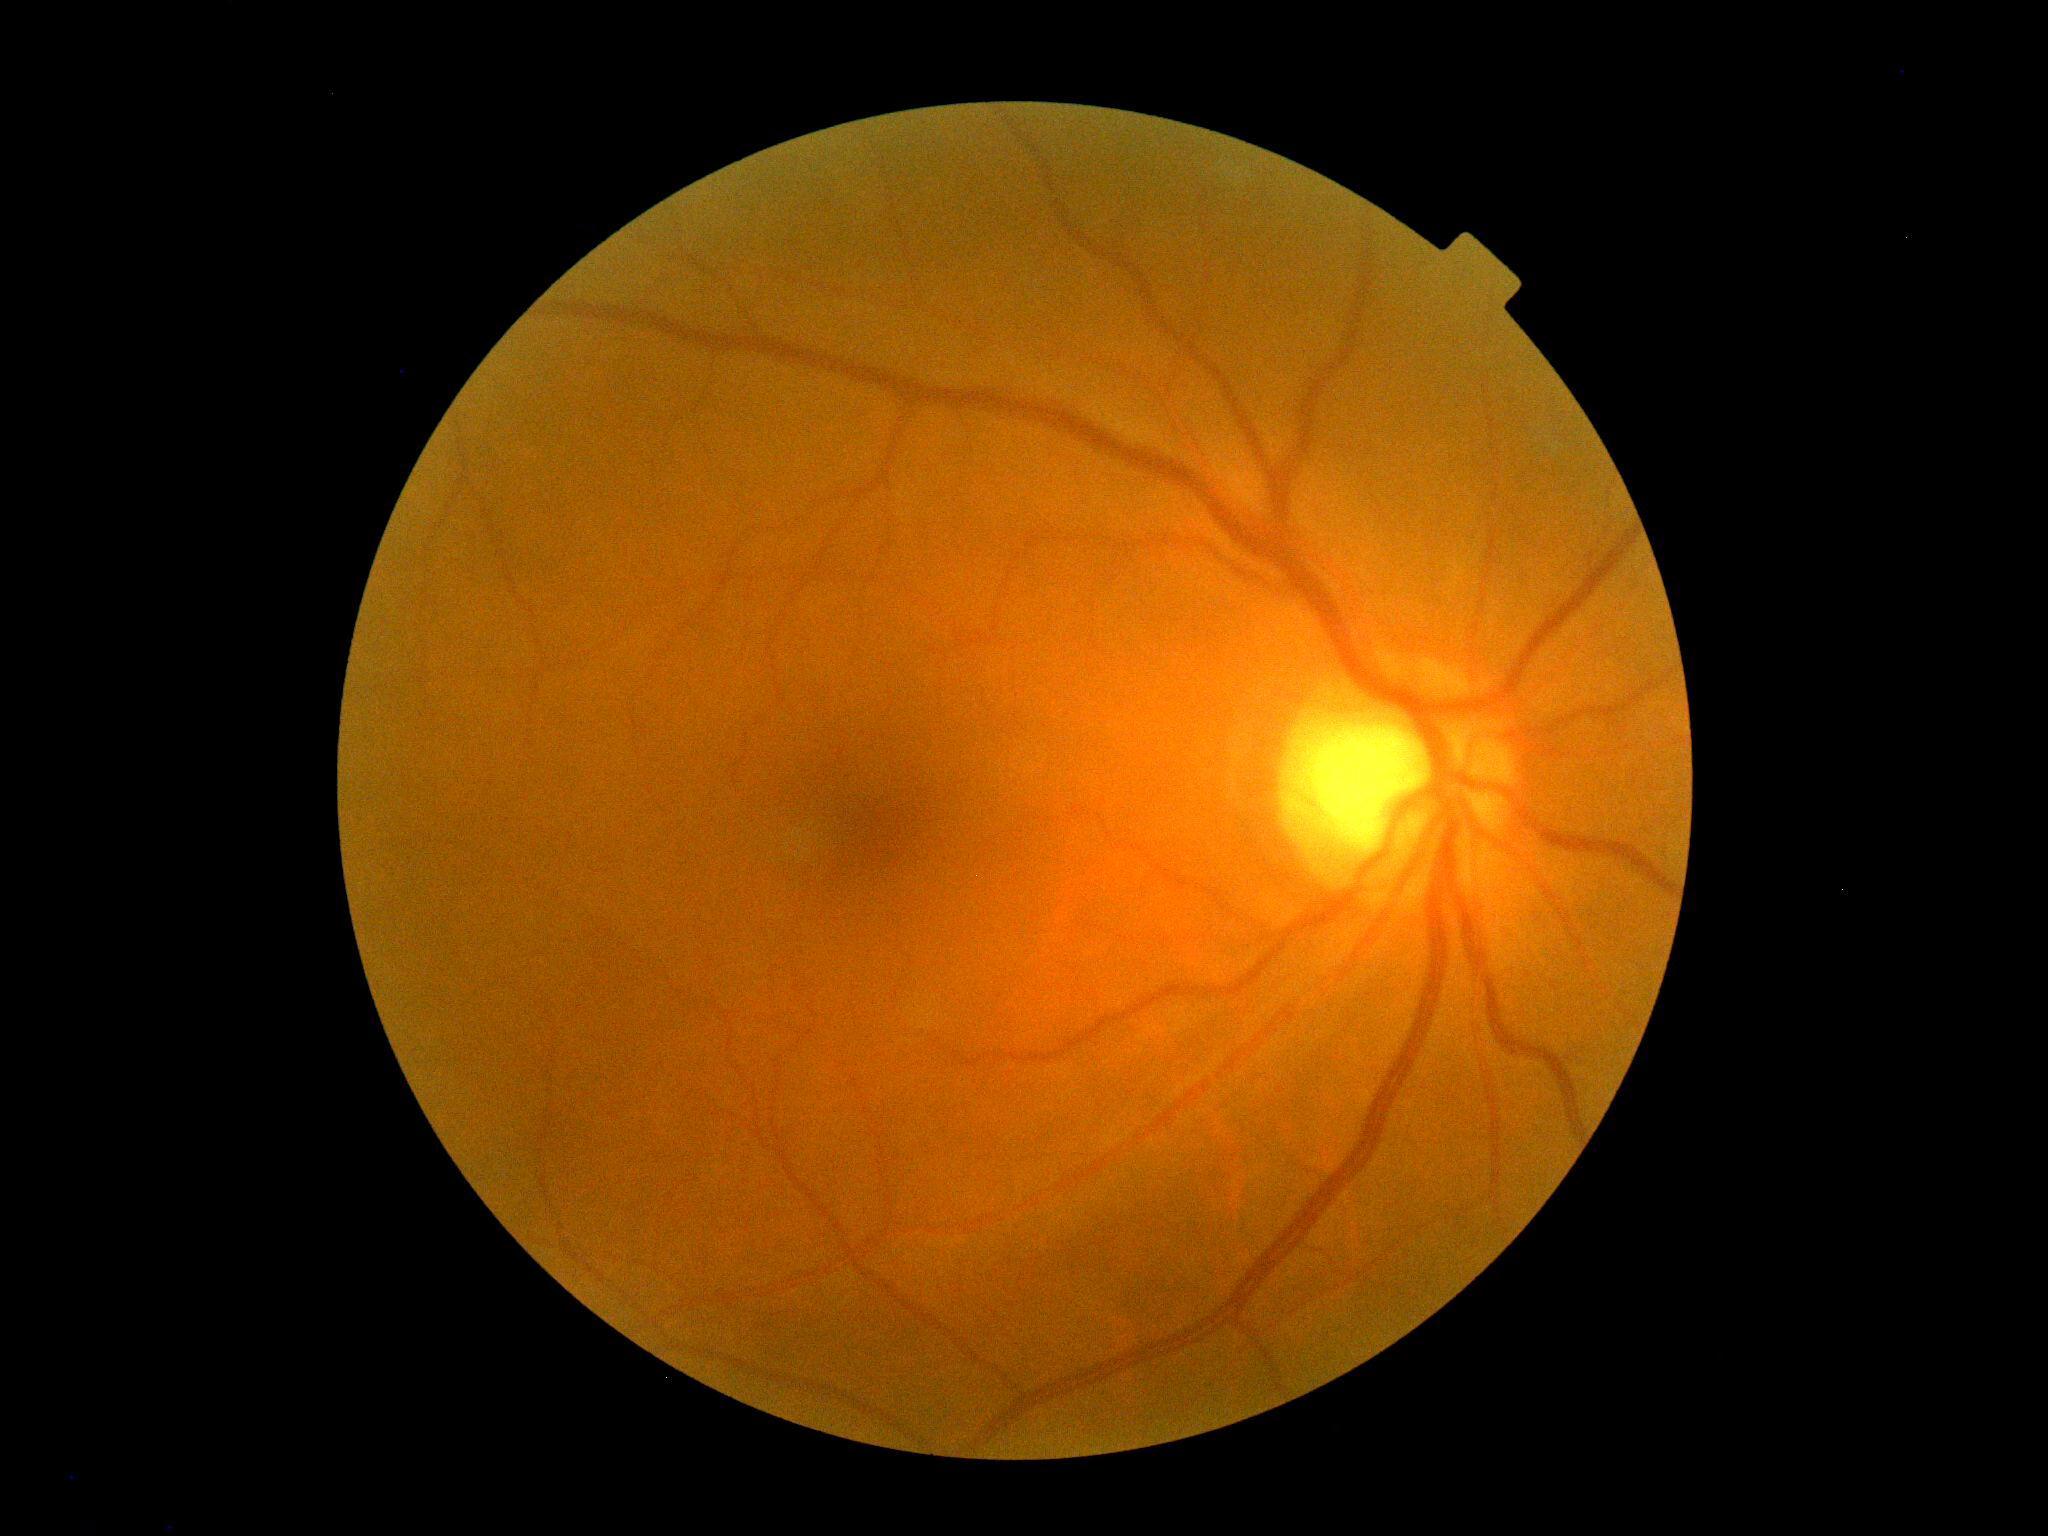 DR grade: 0/4.